NIDEK AFC-230. 848 x 848 pixels. DR severity per modified Davis staging. Posterior pole photograph. Without pupil dilation:
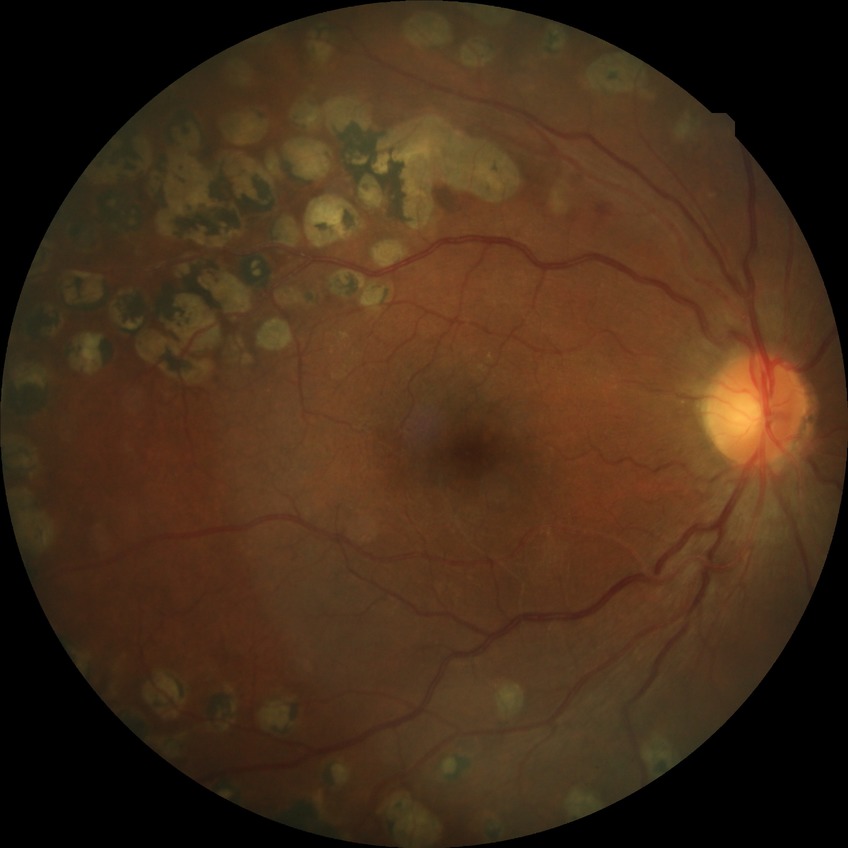

Diabetic retinopathy (DR): PDR (proliferative diabetic retinopathy).